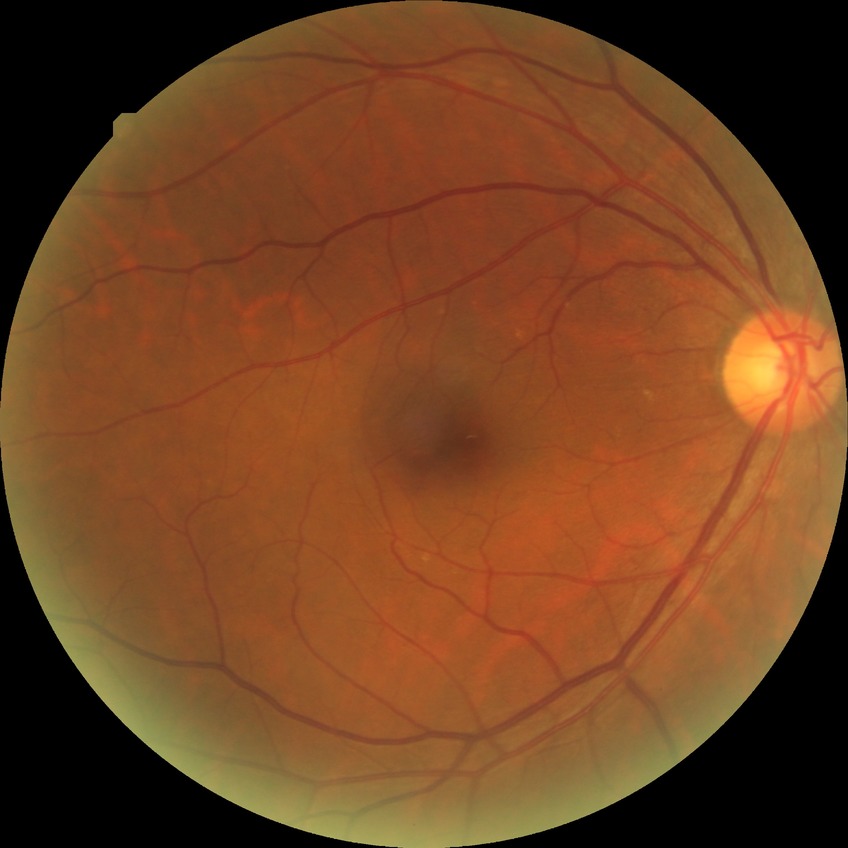 Diabetic retinopathy (DR): NDR (no diabetic retinopathy).